DR severity per modified Davis staging. Nonmydriatic fundus photograph.
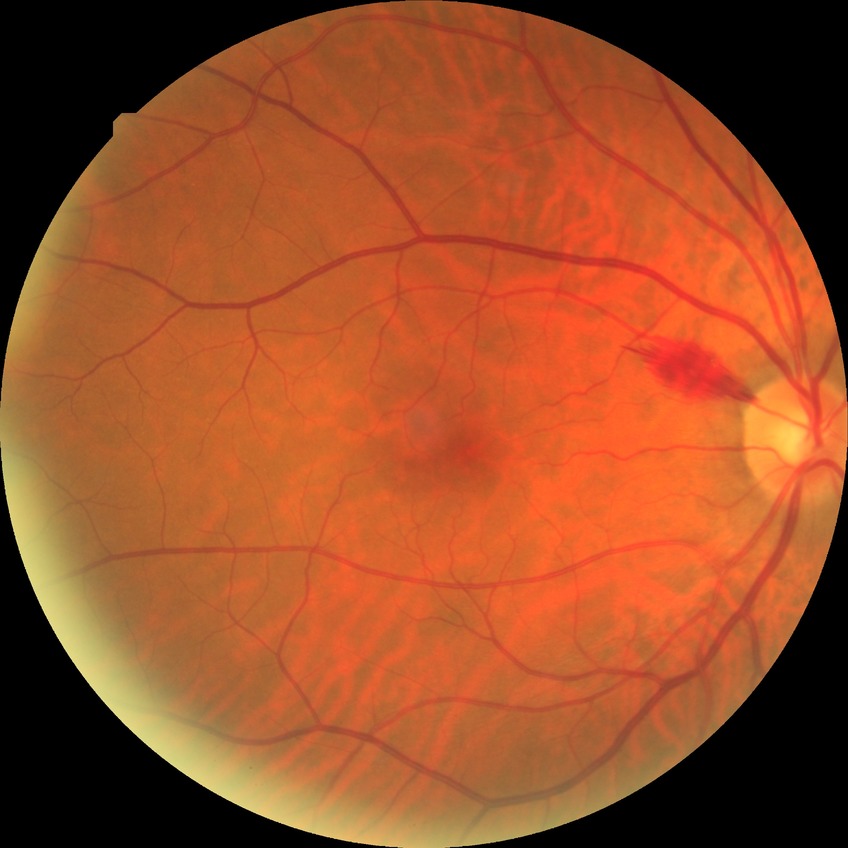
modified Davis classification: no diabetic retinopathy